Ultra-widefield fundus mosaic — 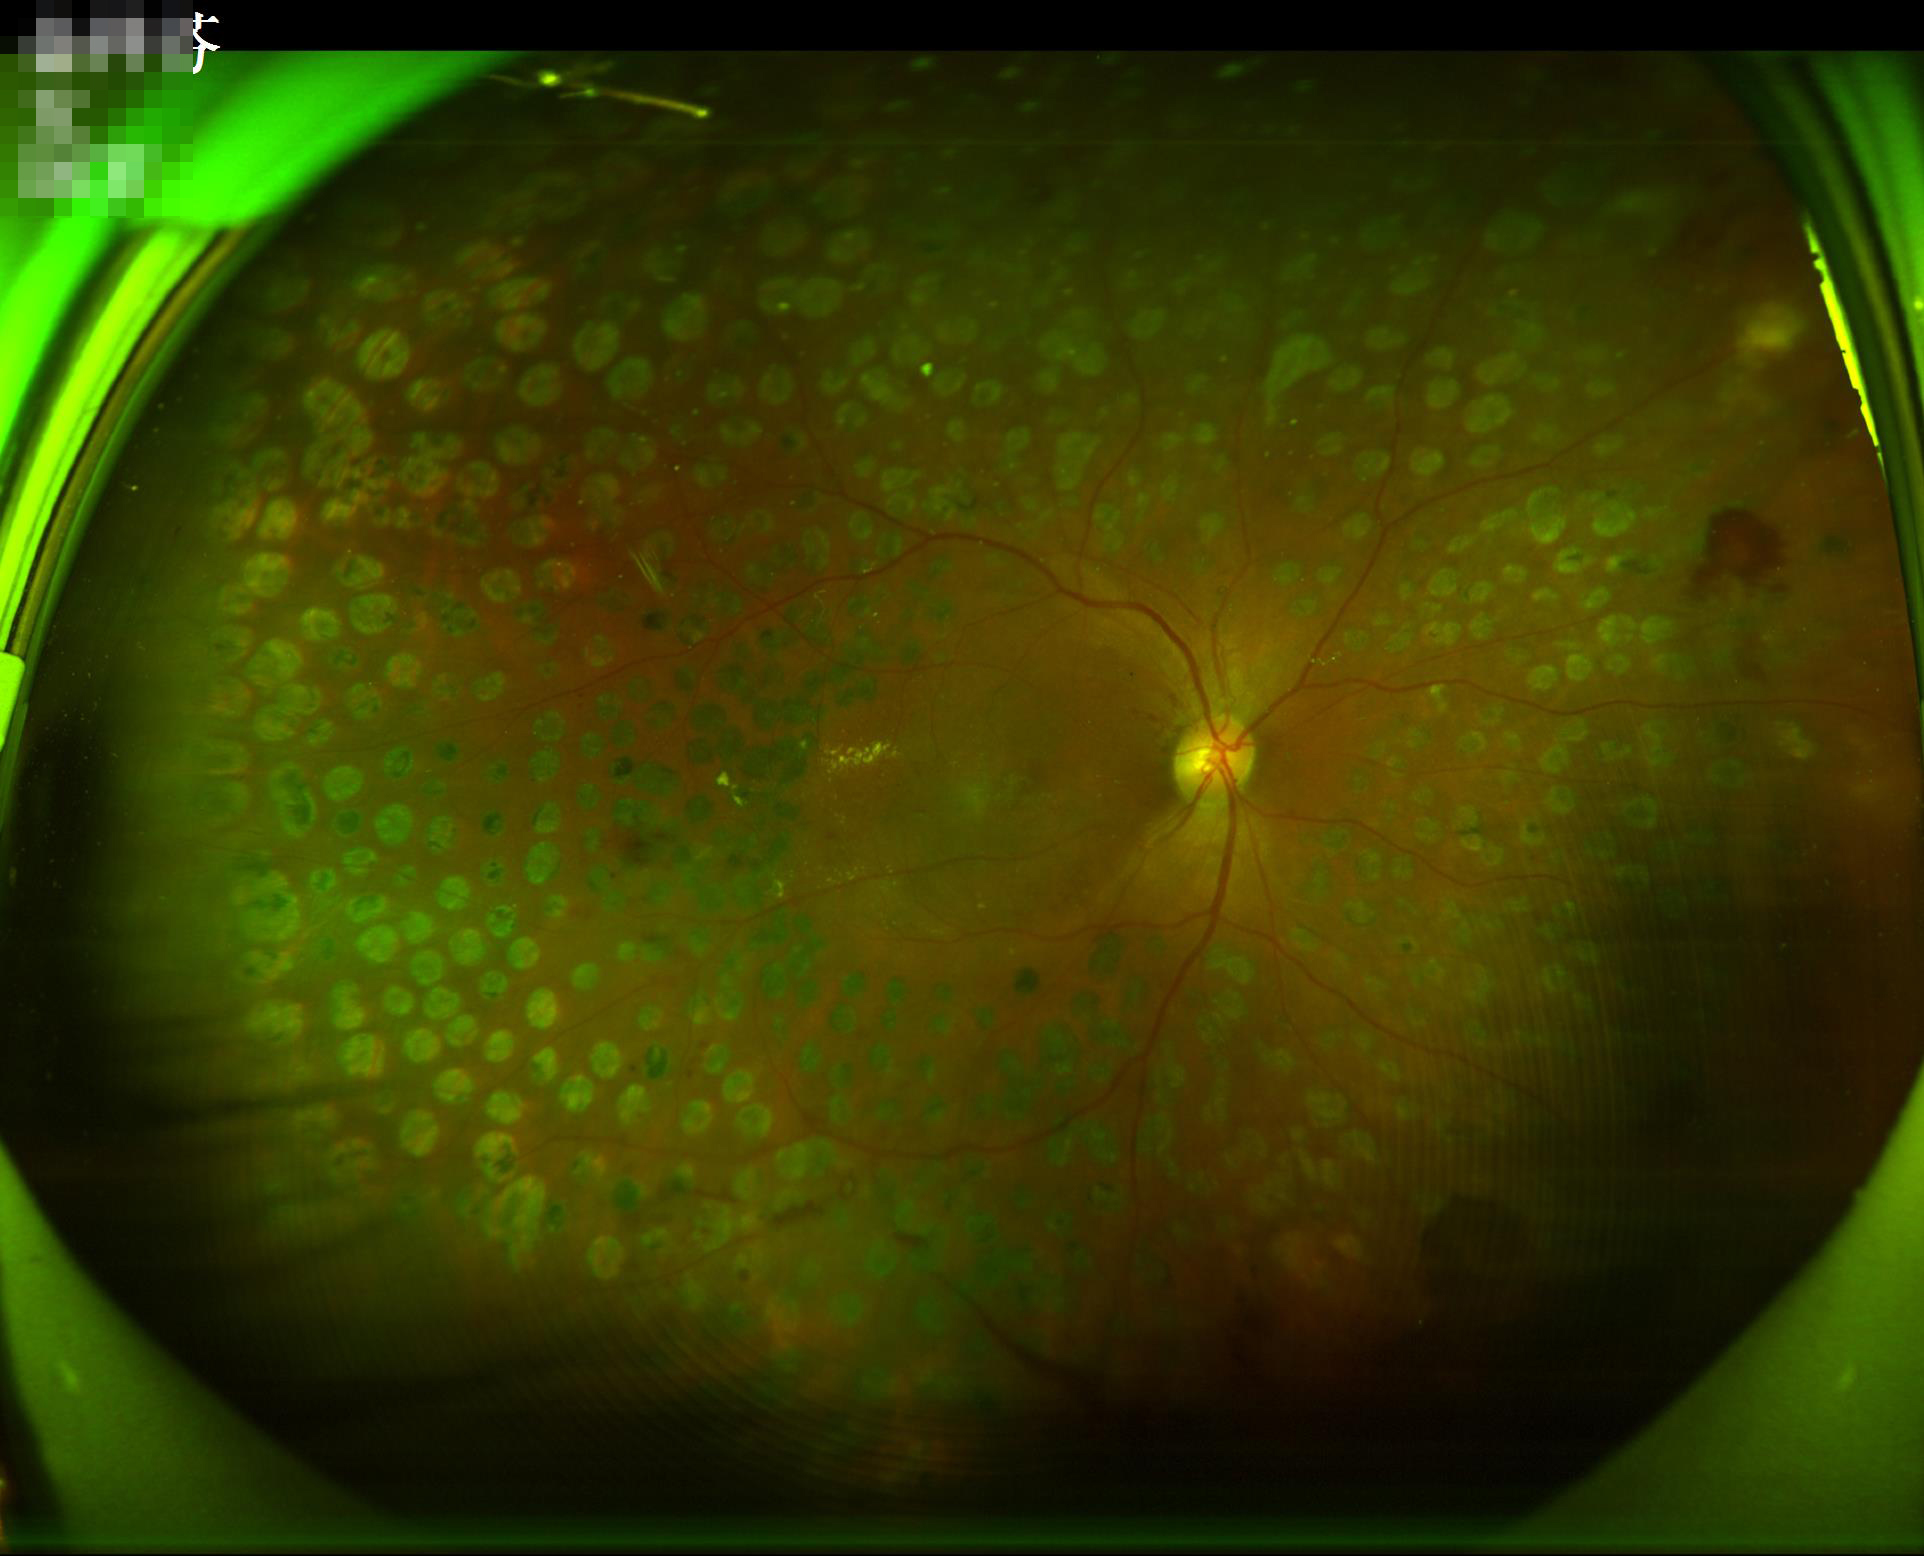 Illumination is uneven.
No noticeable blur.